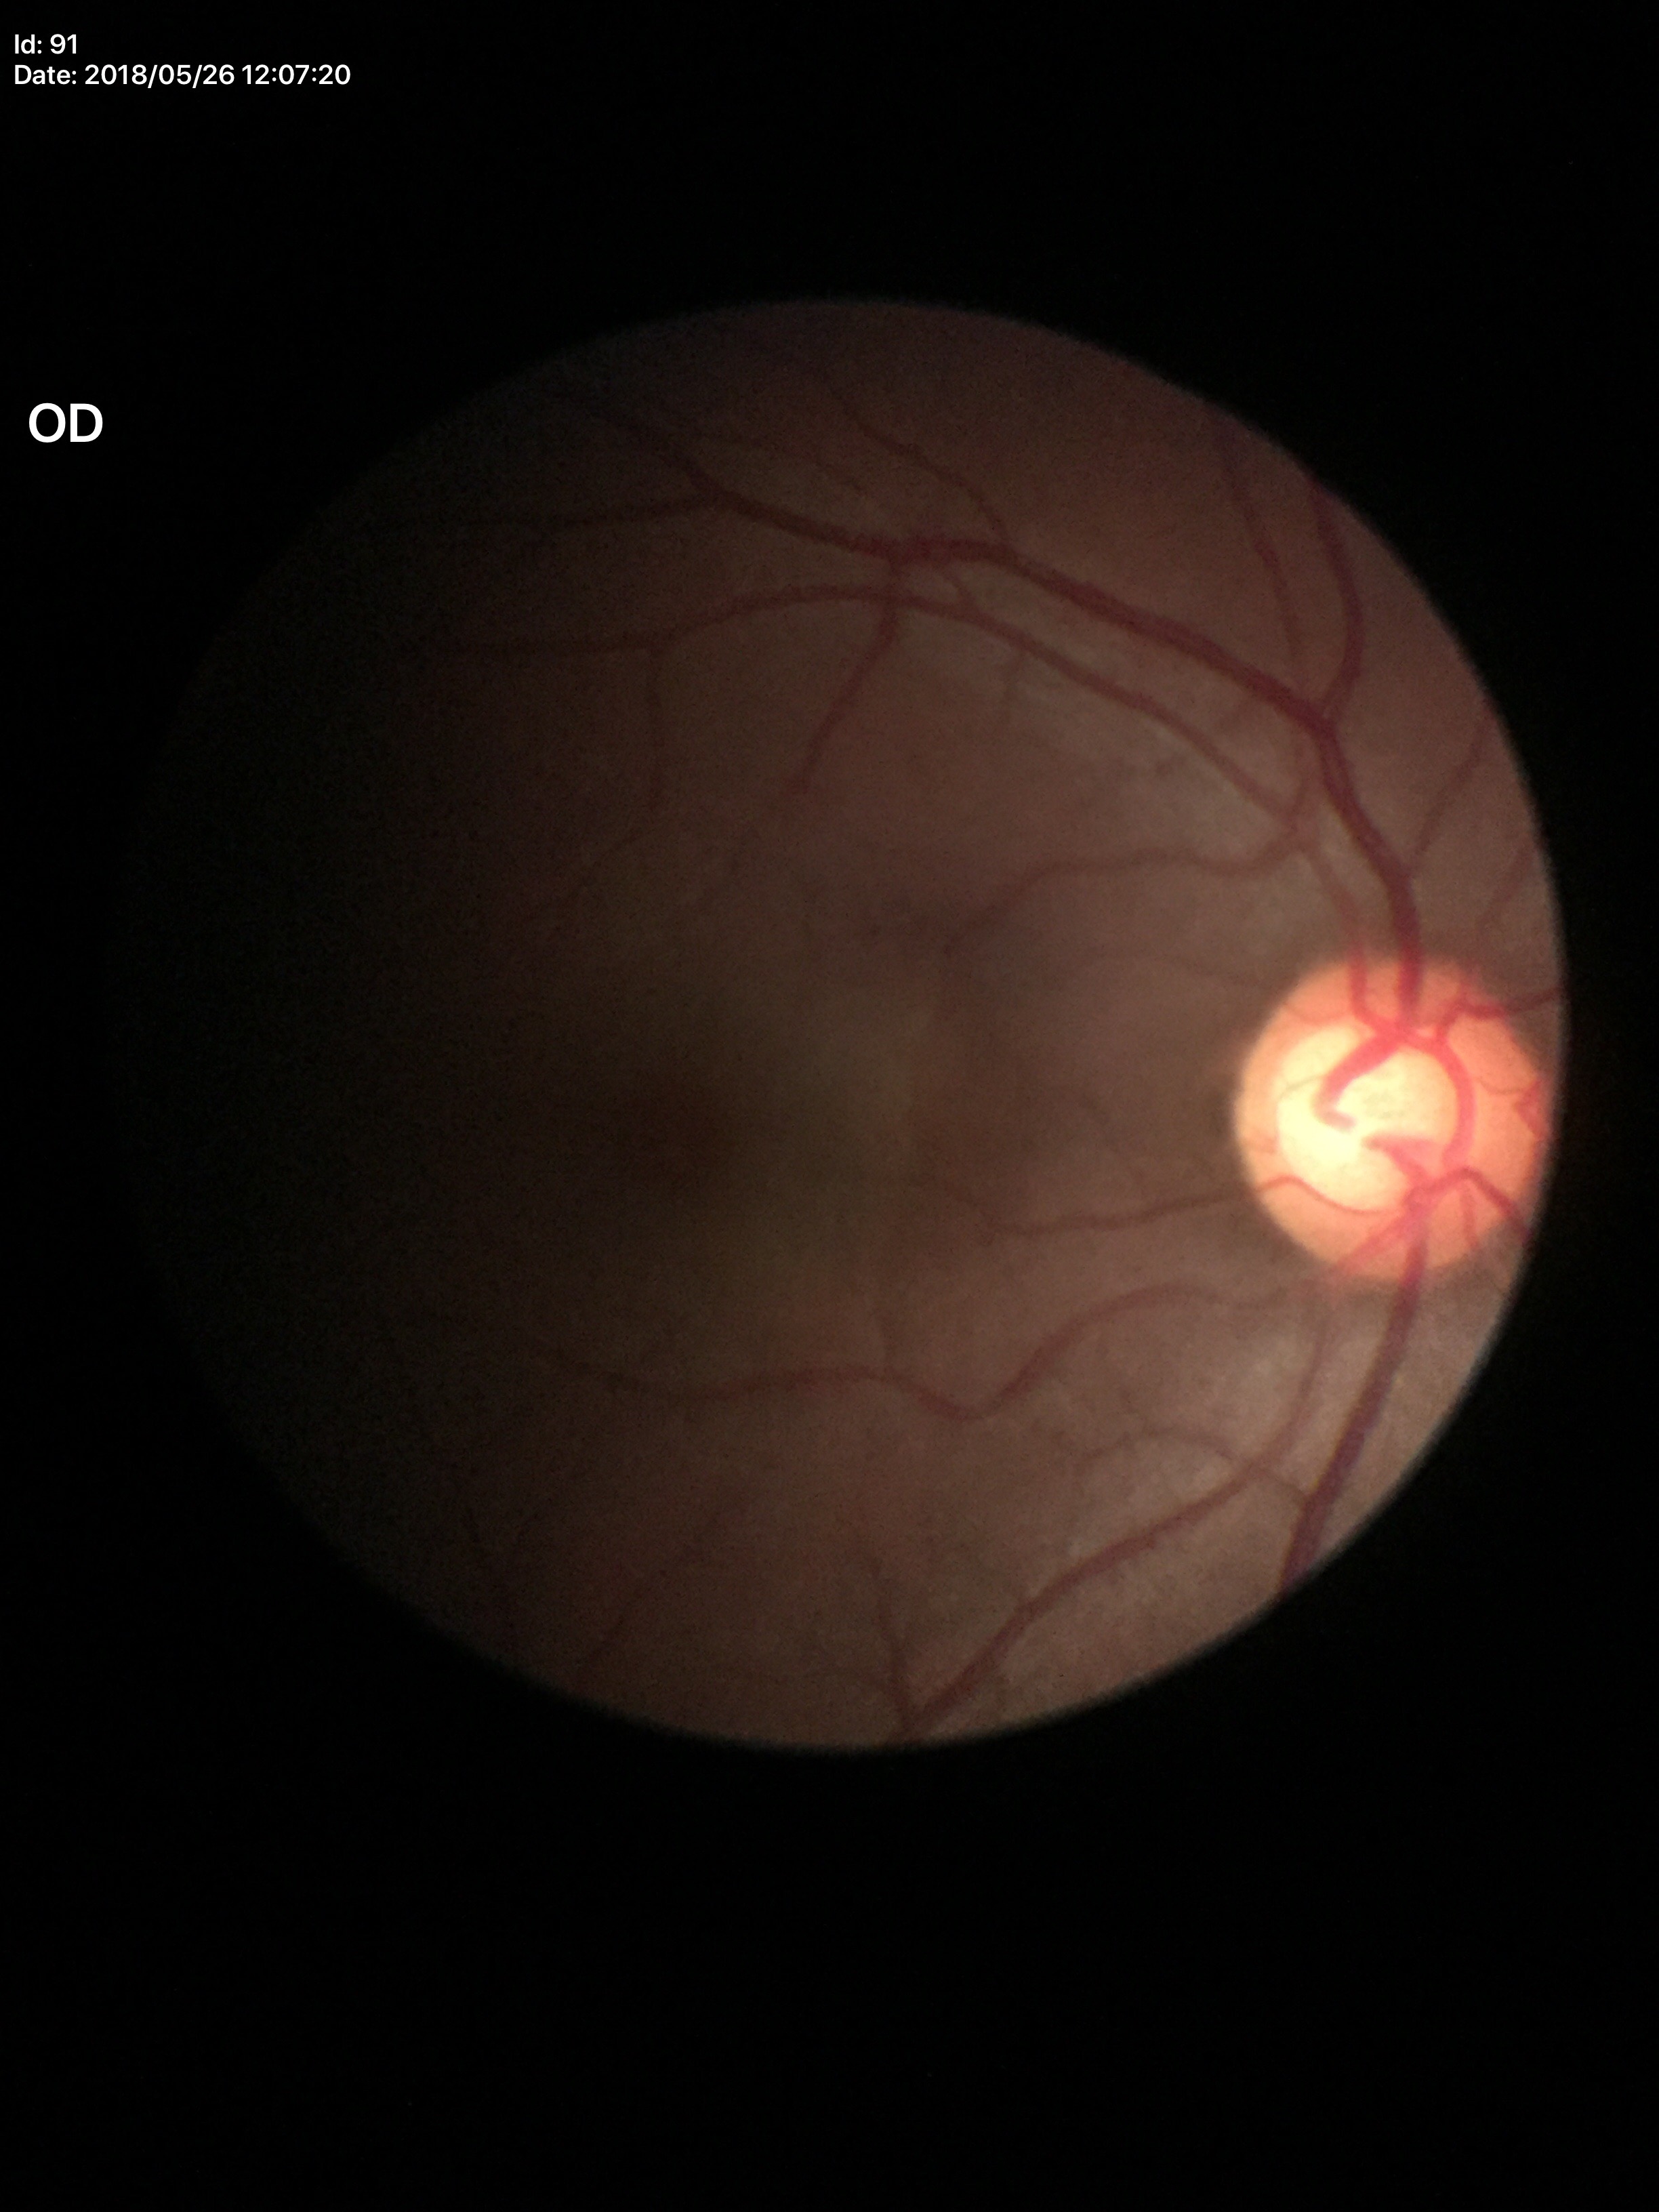
VCDR=0.64
Glaucoma assessment=suspect